No pharmacologic dilation — 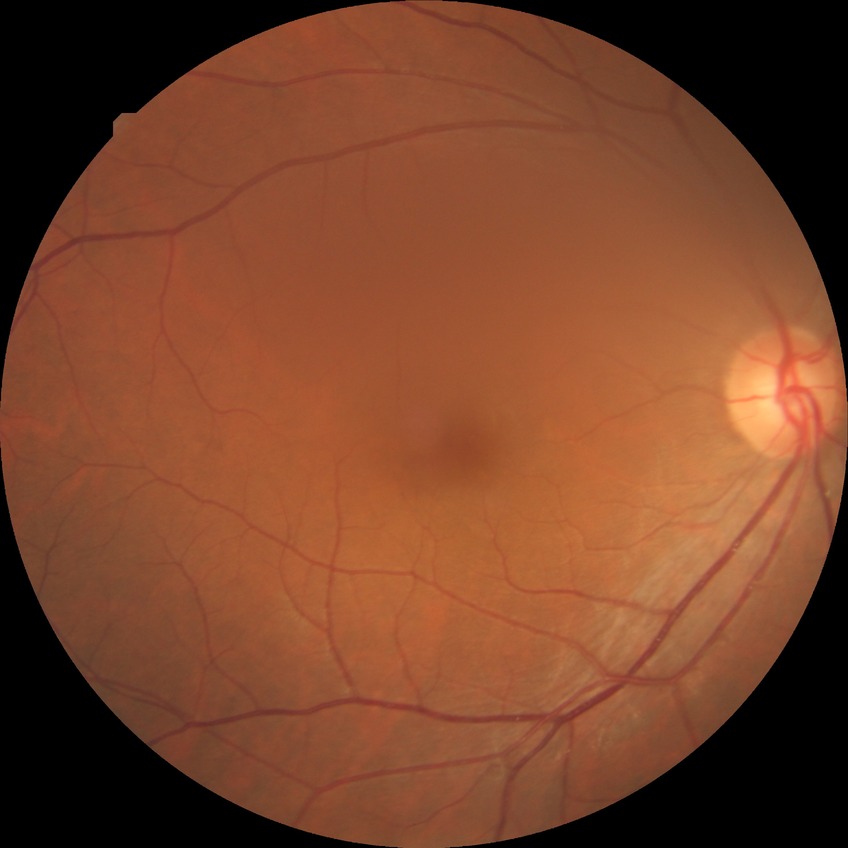
Modified Davis grading is no diabetic retinopathy.